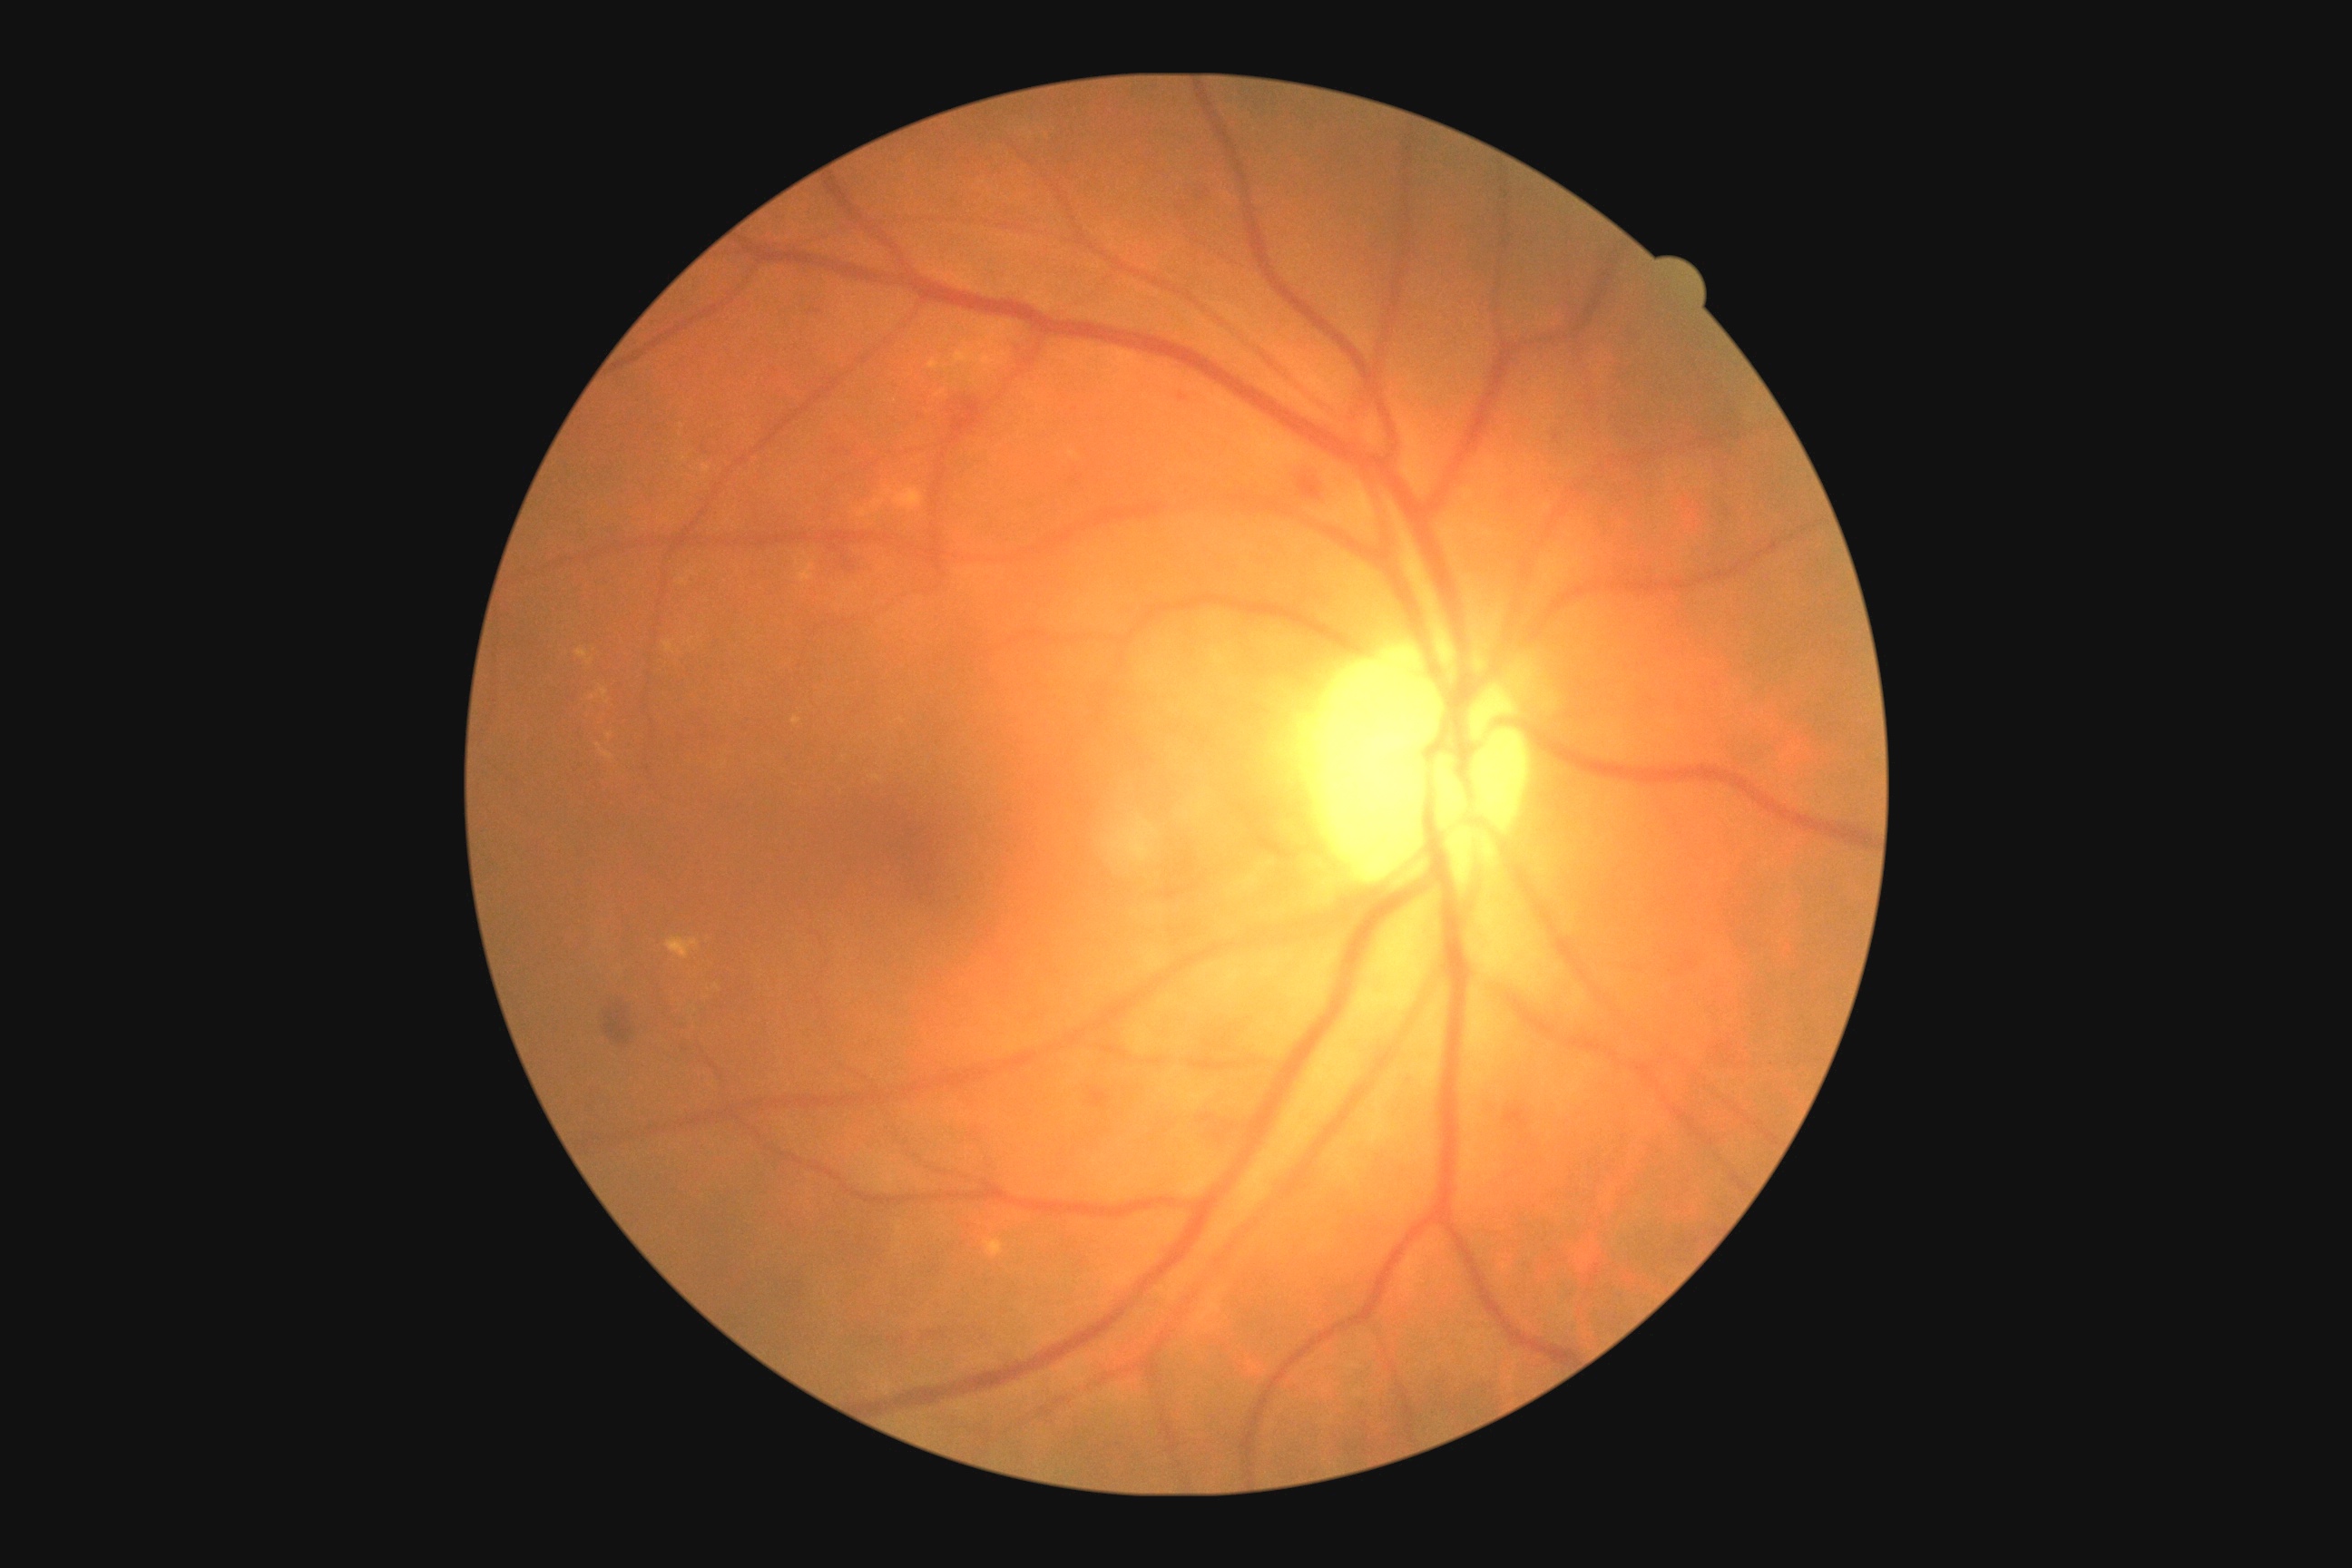
DR grade: 2/4.